50° field of view
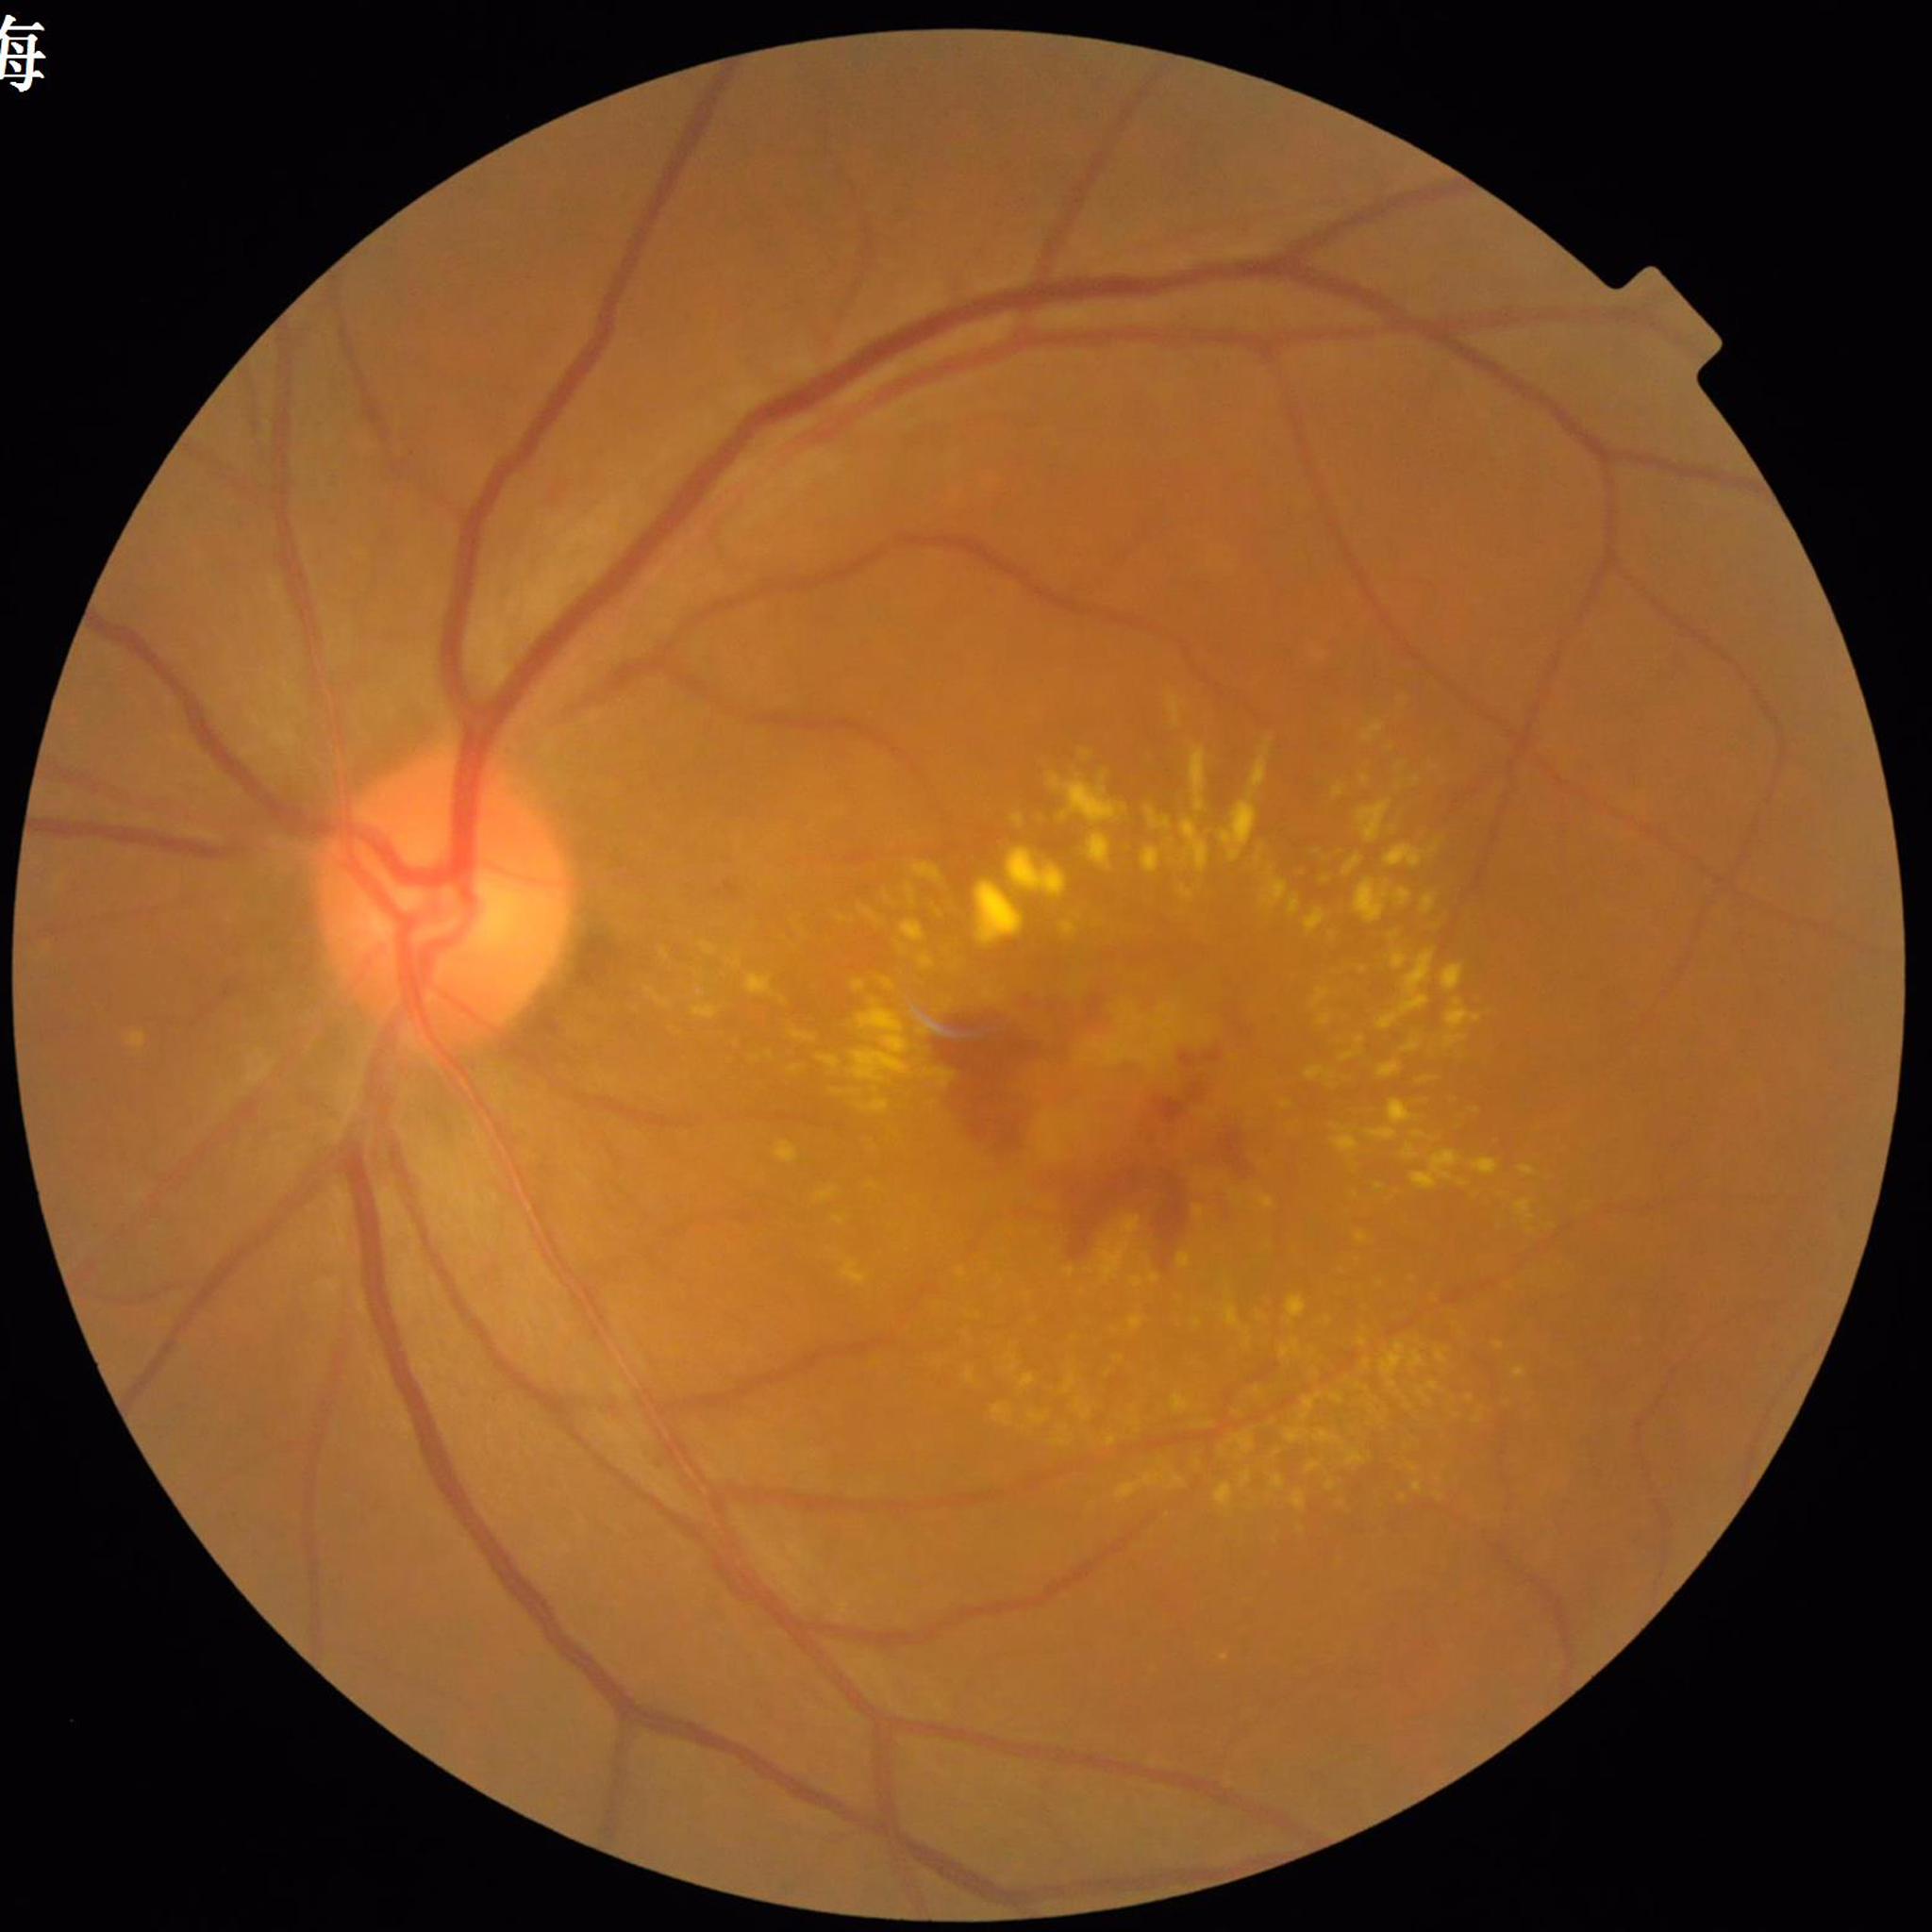
From a patient with age-related macular degeneration.